Camera: Clarity RetCam 3 (130° FOV); 640 x 480 pixels; pediatric wide-field fundus photograph — 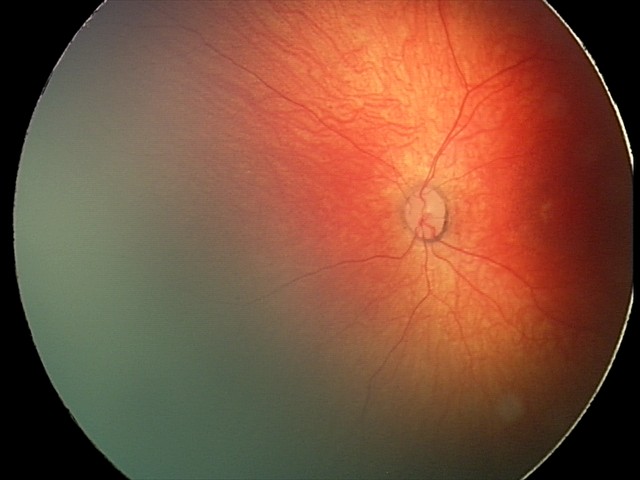

Physiological retinal appearance for postconceptual age.